2212x1661px; captured on a Topcon TRC-NW400 fundus camera — 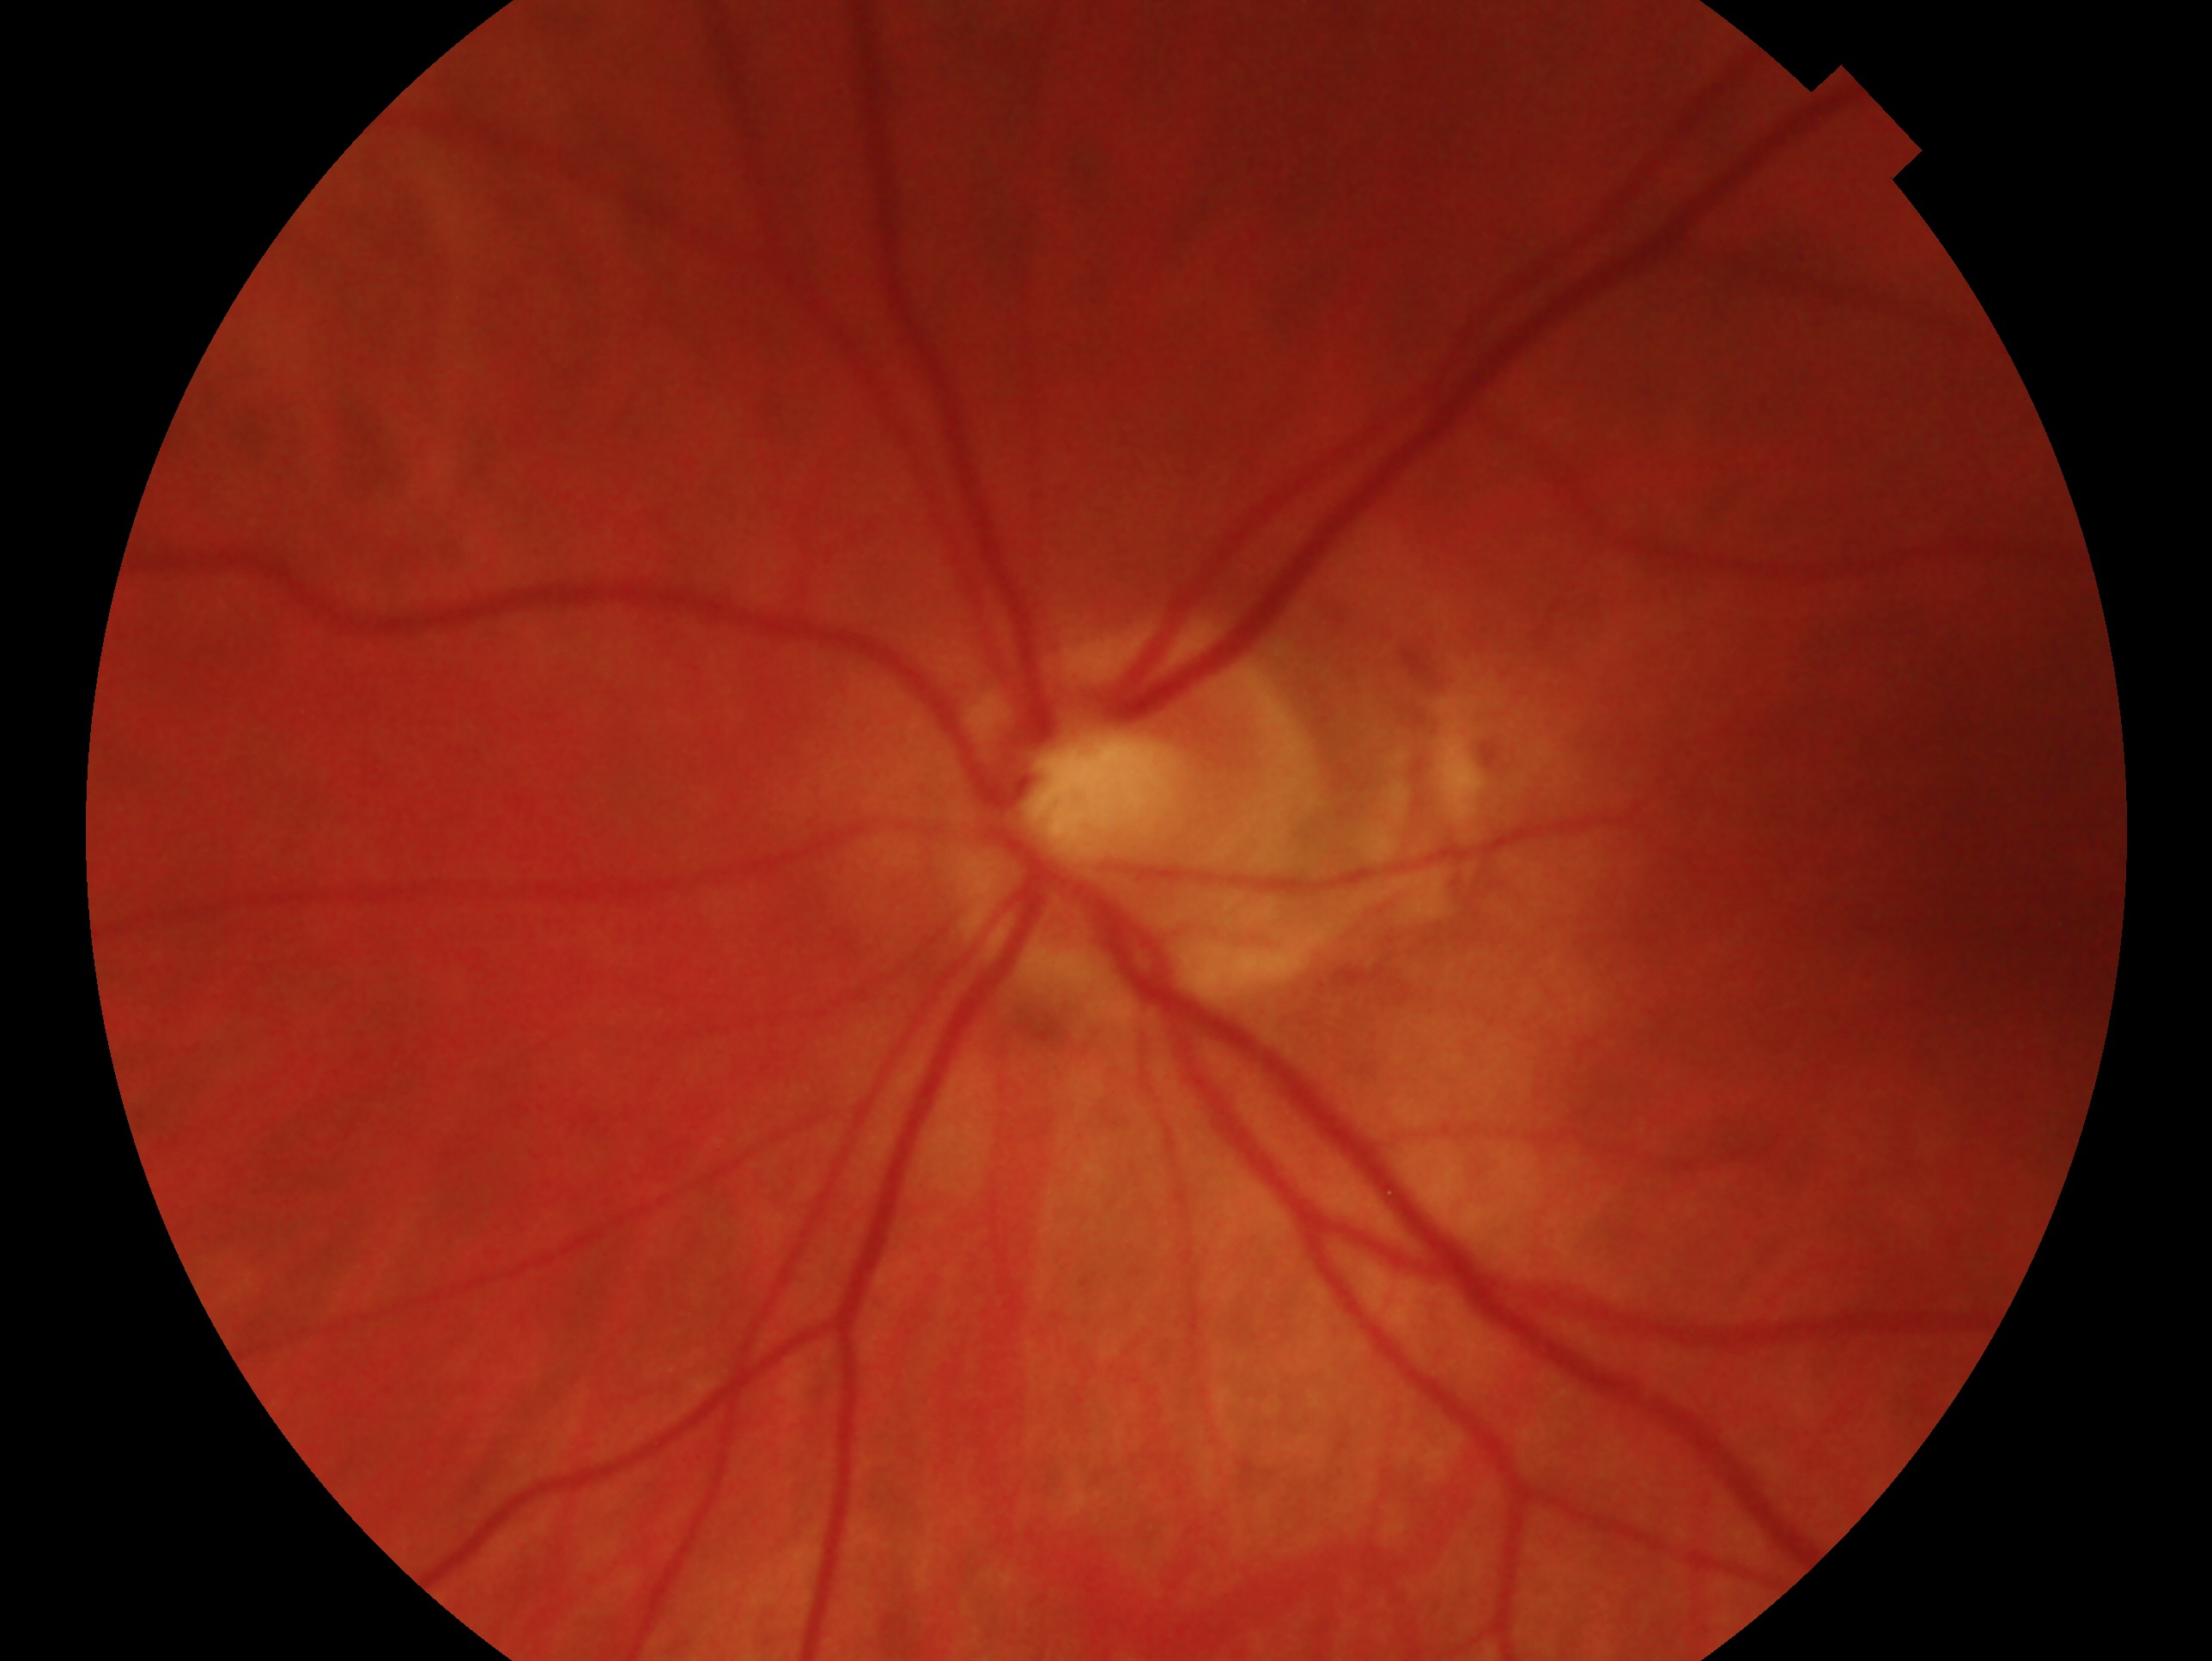 laterality: oculus sinister | glaucoma status: no glaucoma — no clinical evidence of glaucoma in this eye.